CFP; 45° field of view; 2048 by 1536 pixels:
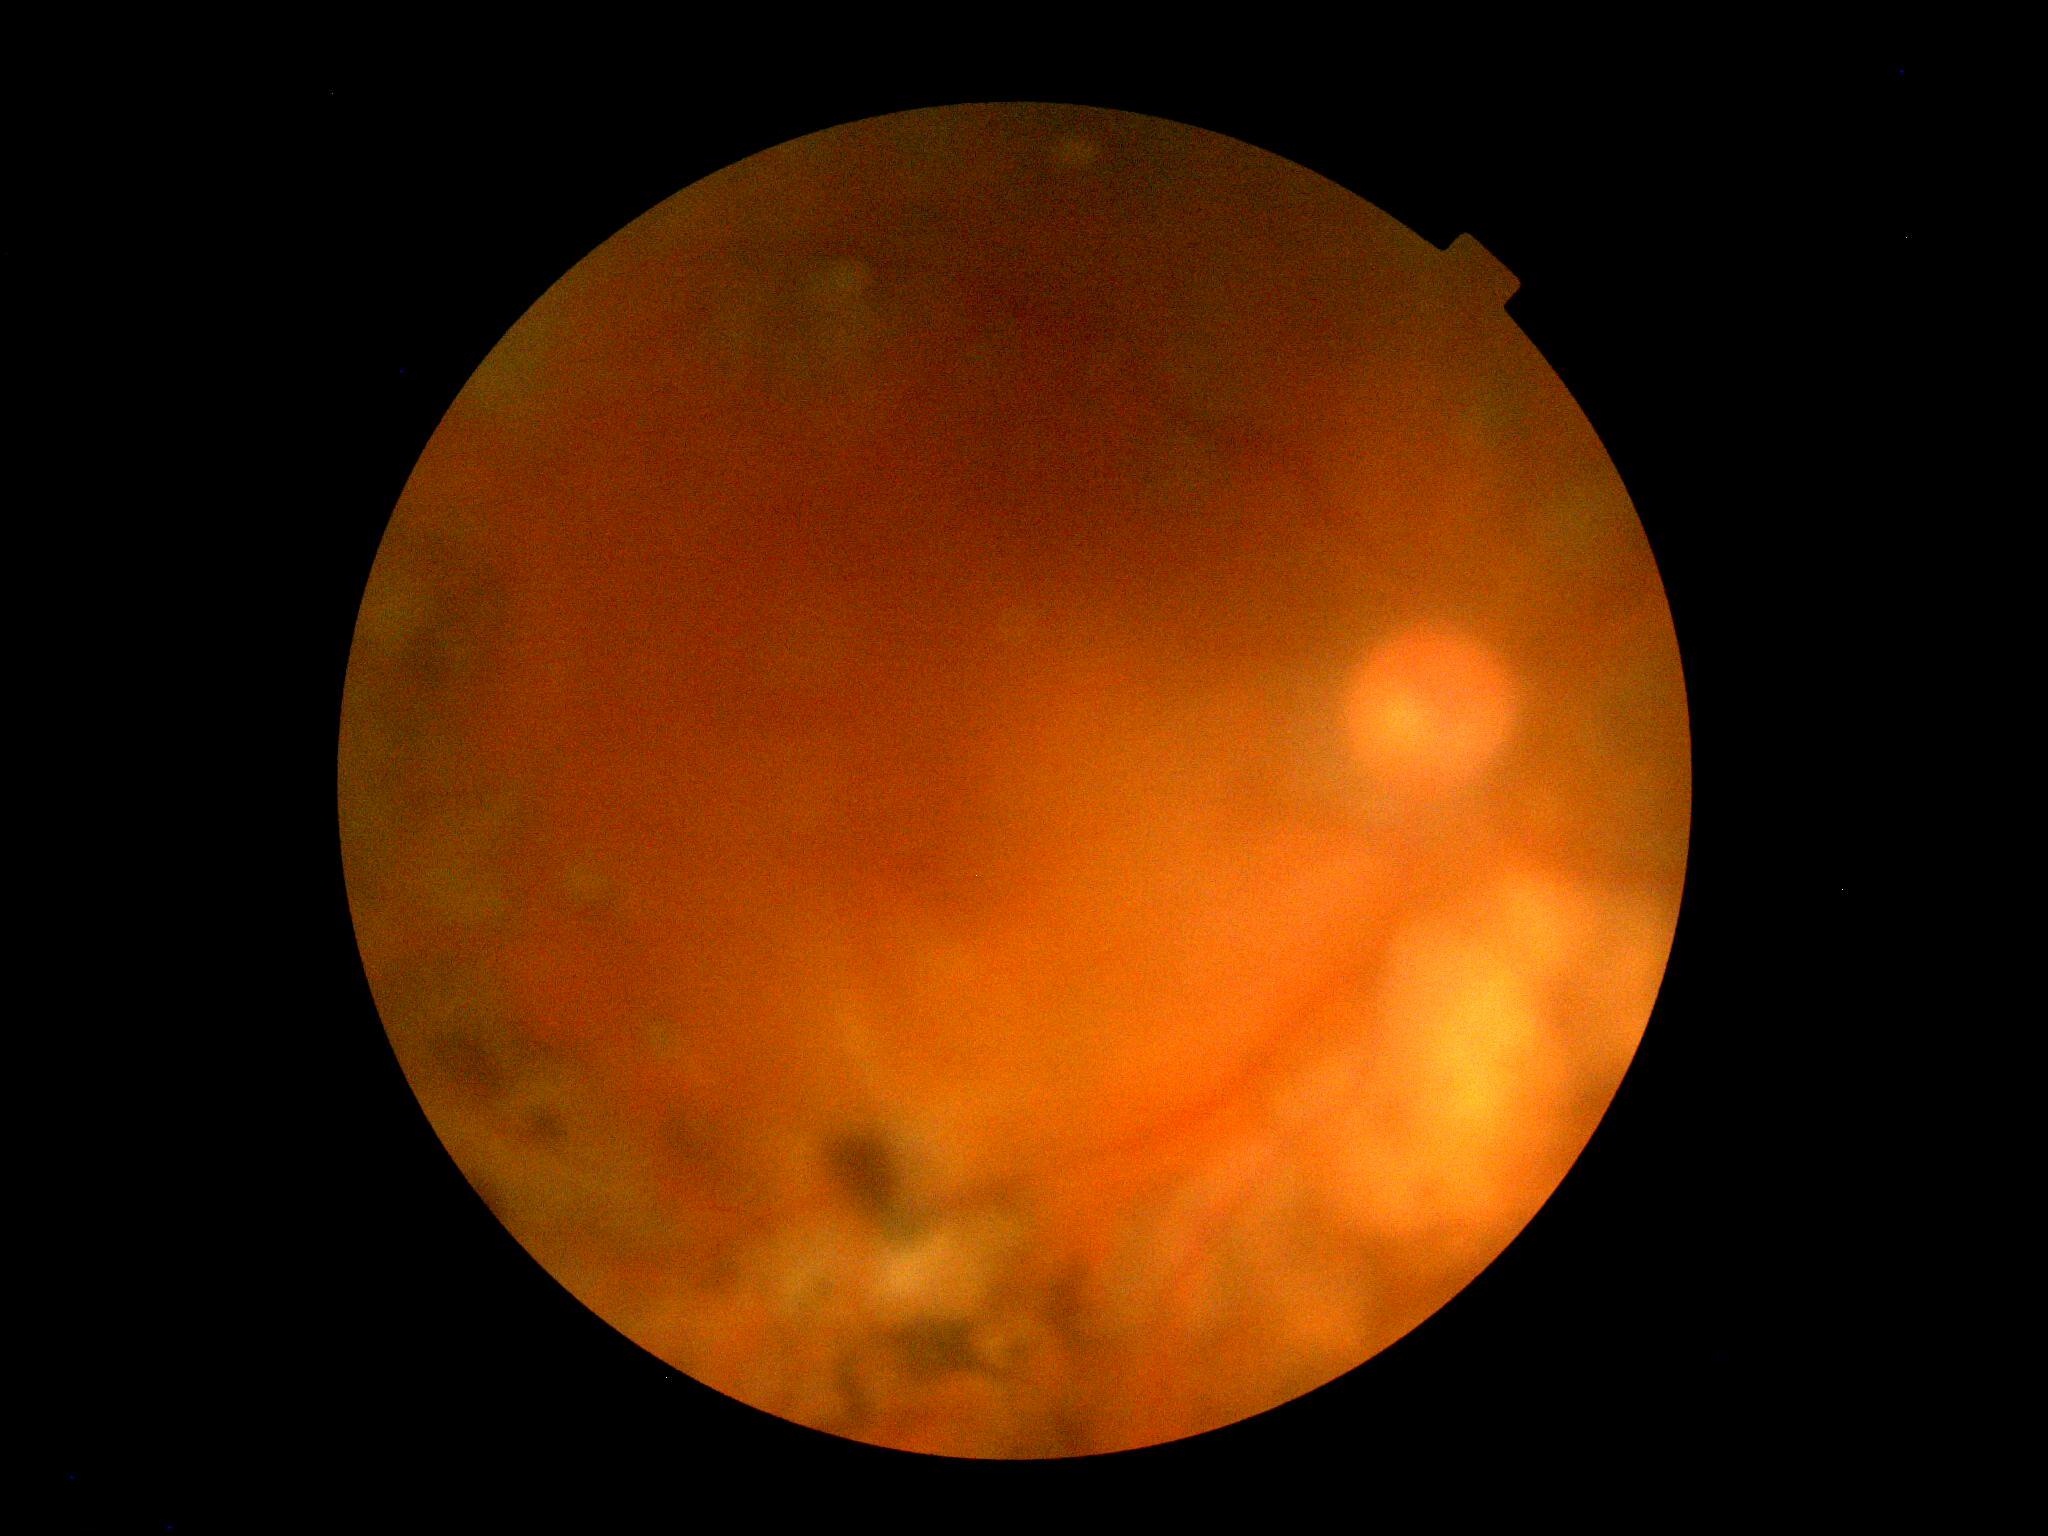 Quality too poor to assess for DR.
Diabetic retinopathy (DR) is ungradable.